NIDEK AFC-230 fundus camera, 45 degree fundus photograph, retinal fundus photograph — 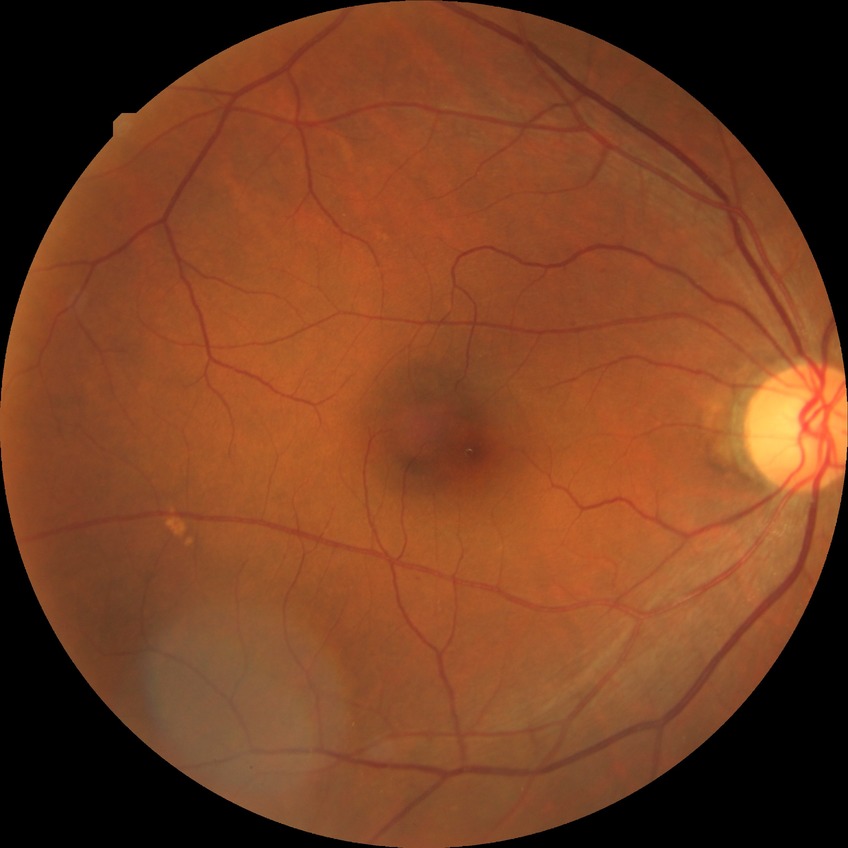
Diabetic retinopathy (DR) is SDR (simple diabetic retinopathy).